Image size 848x848. Graded on the modified Davis scale
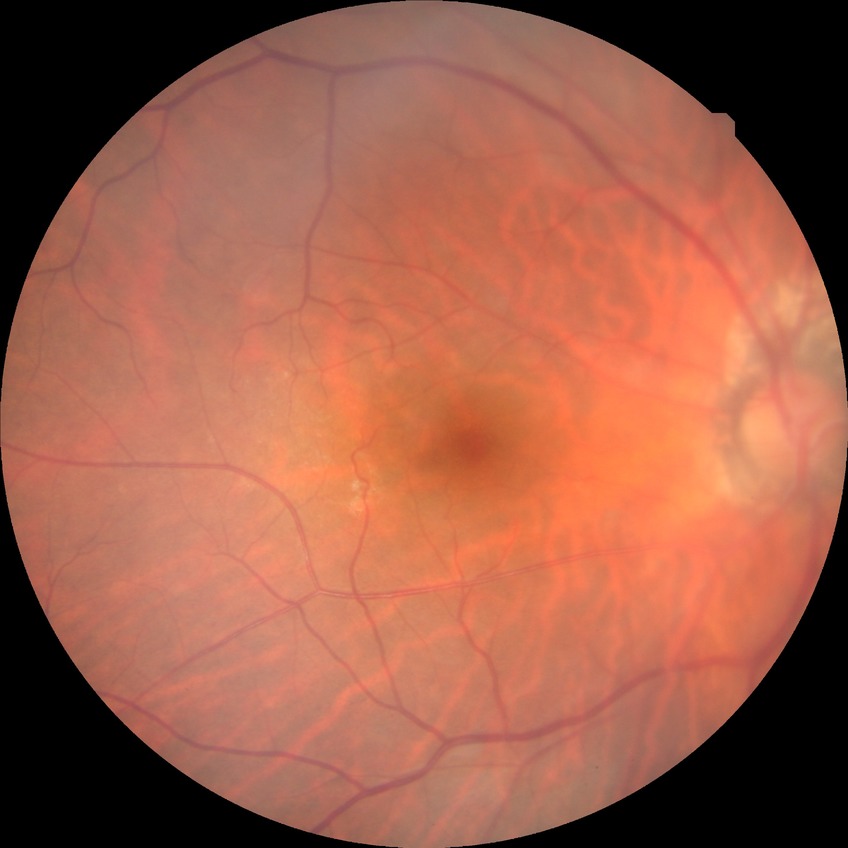

Retinopathy grade is no diabetic retinopathy.